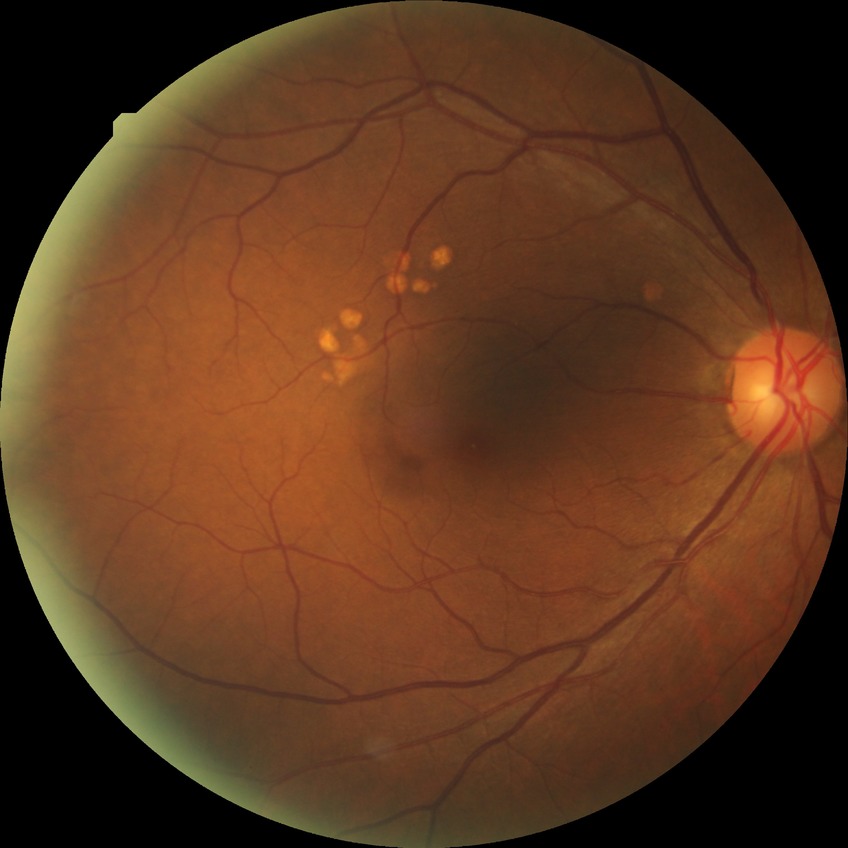
DR stage: NDR.